Wide-field contact fundus photograph of an infant — 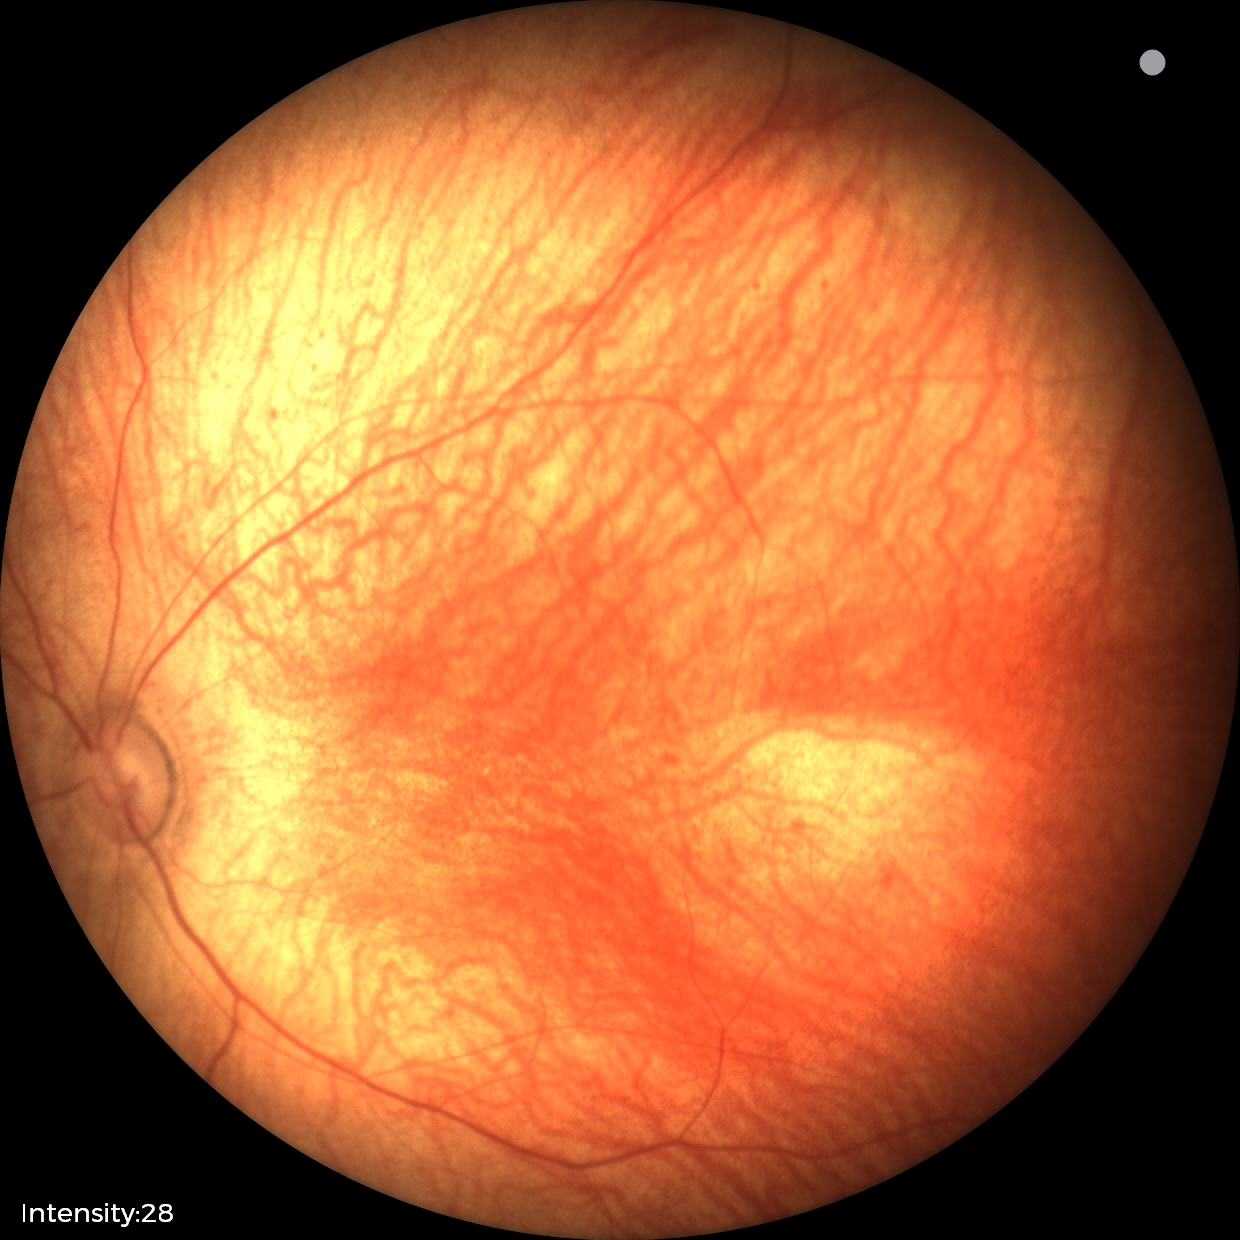

Physiological retinal appearance for postconceptual age.